Color fundus image.
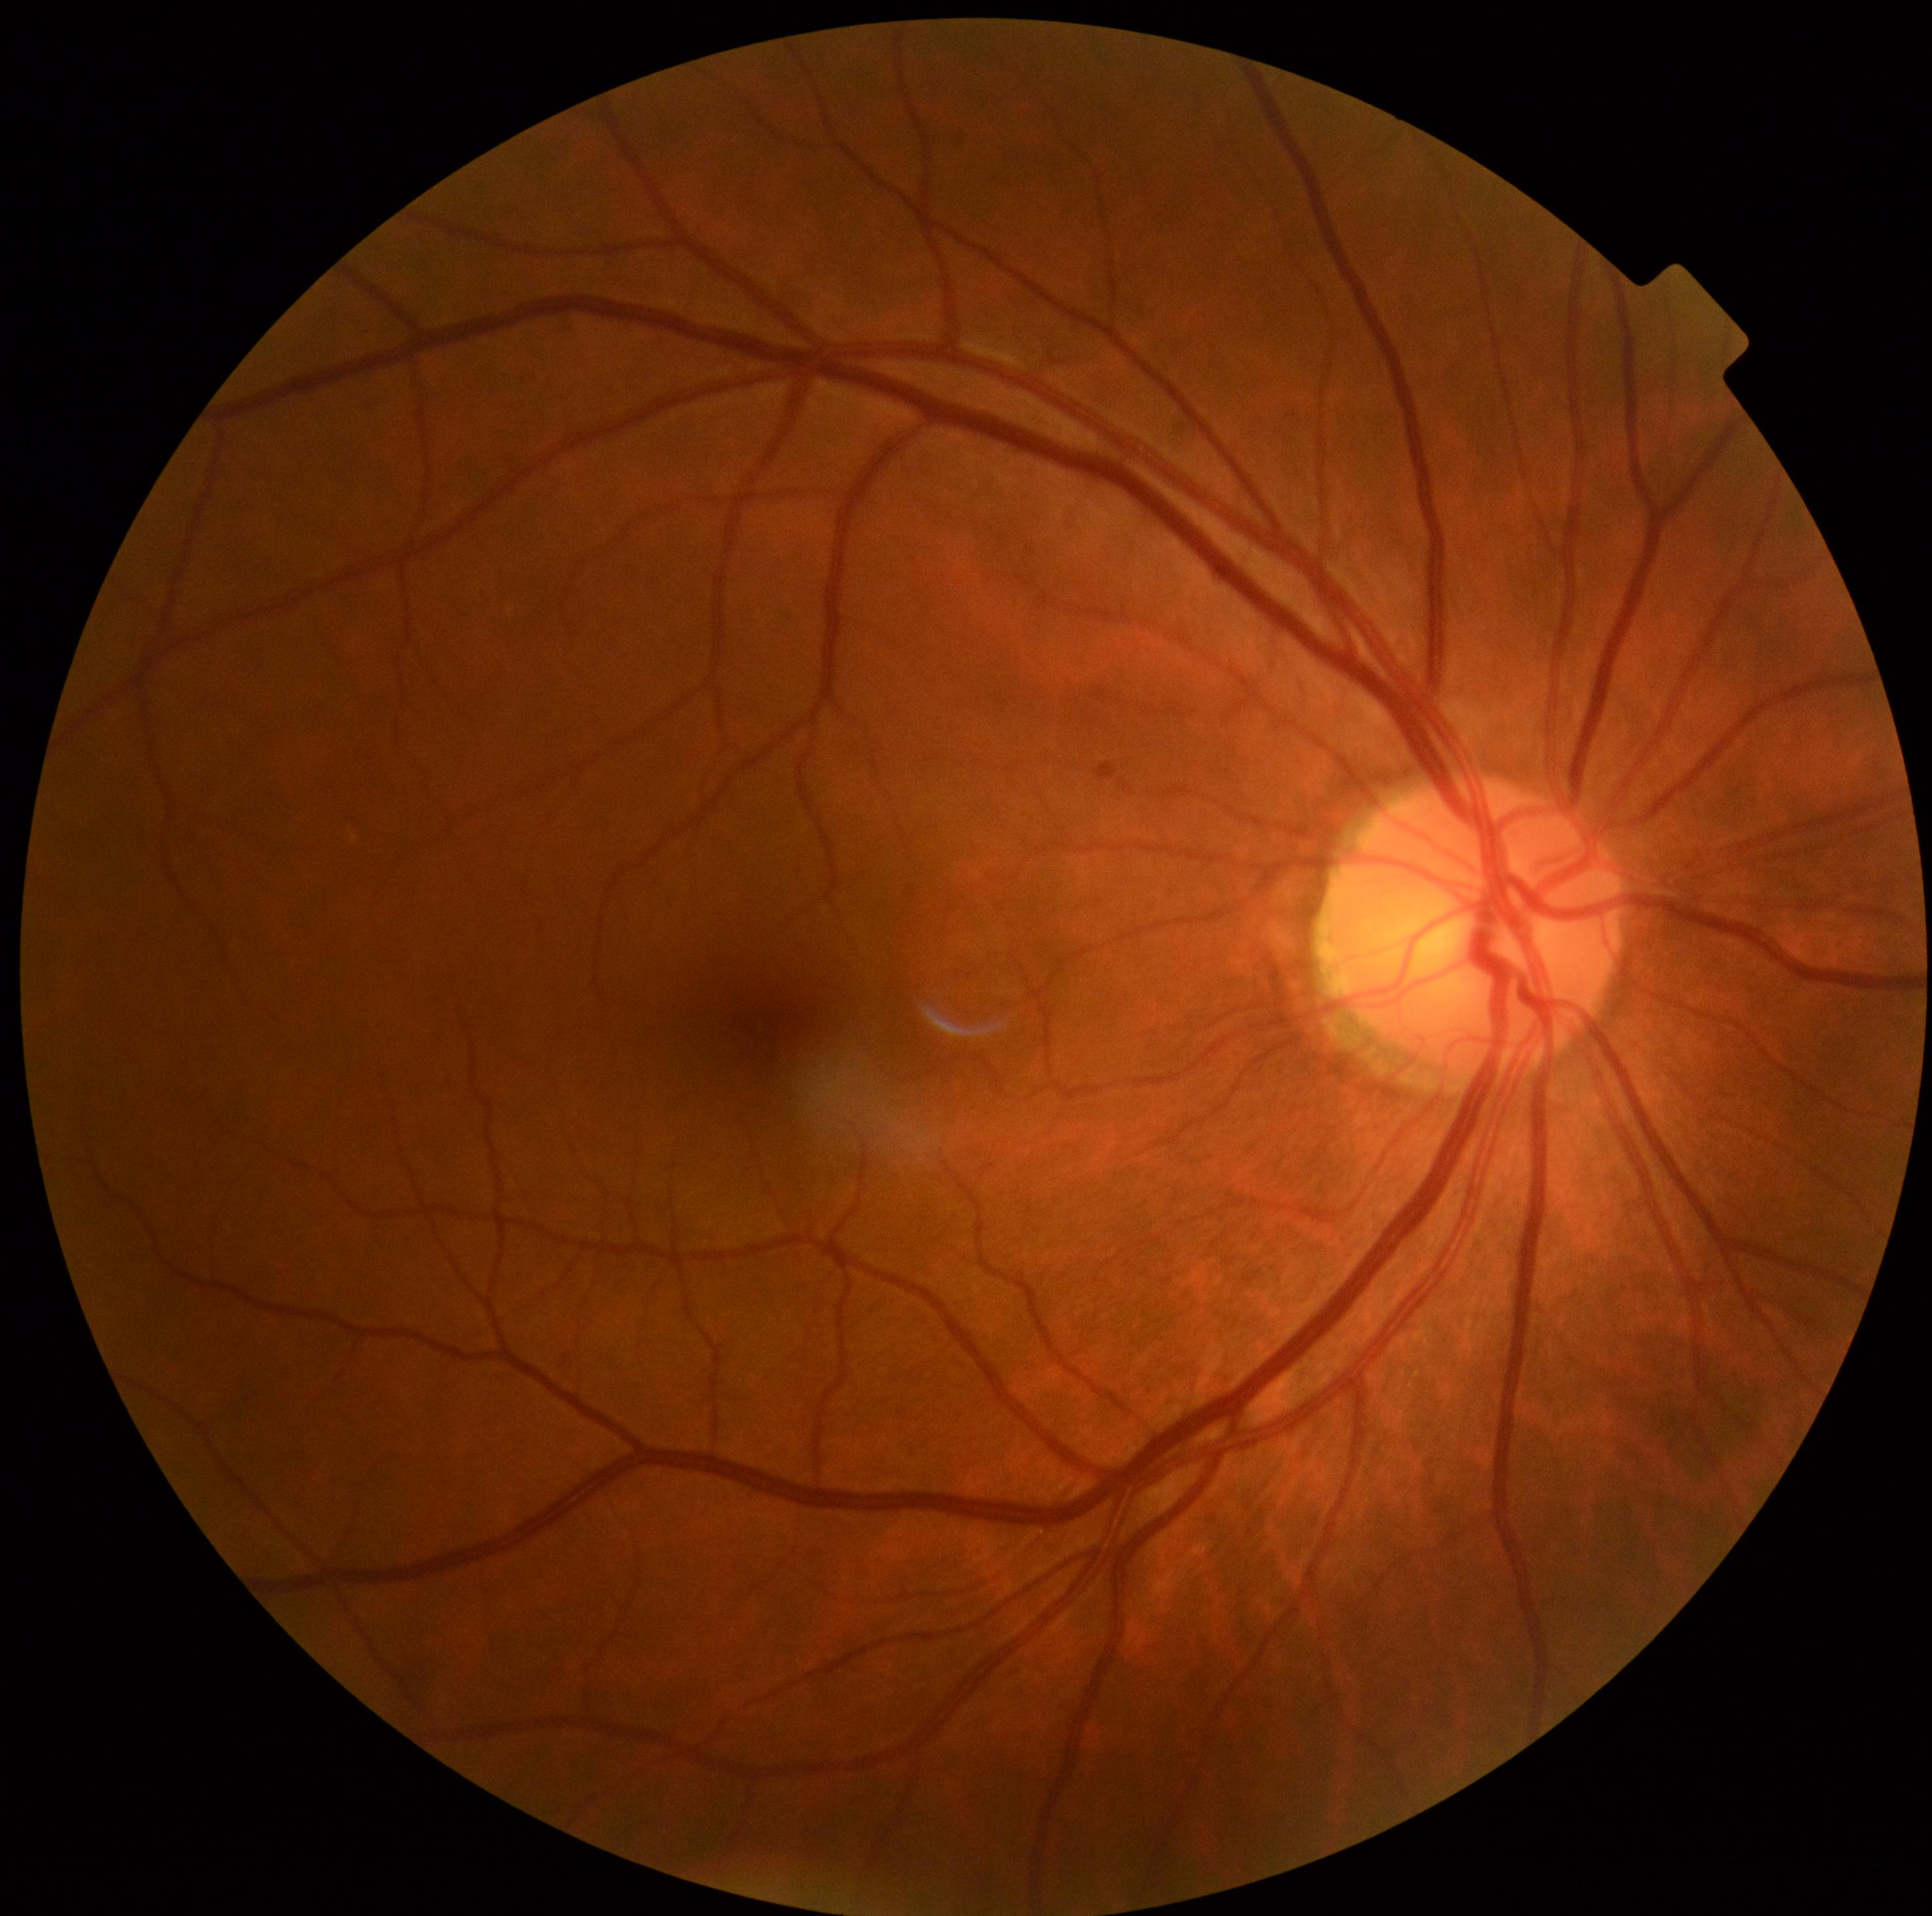

Diabetic retinopathy: 0/4.